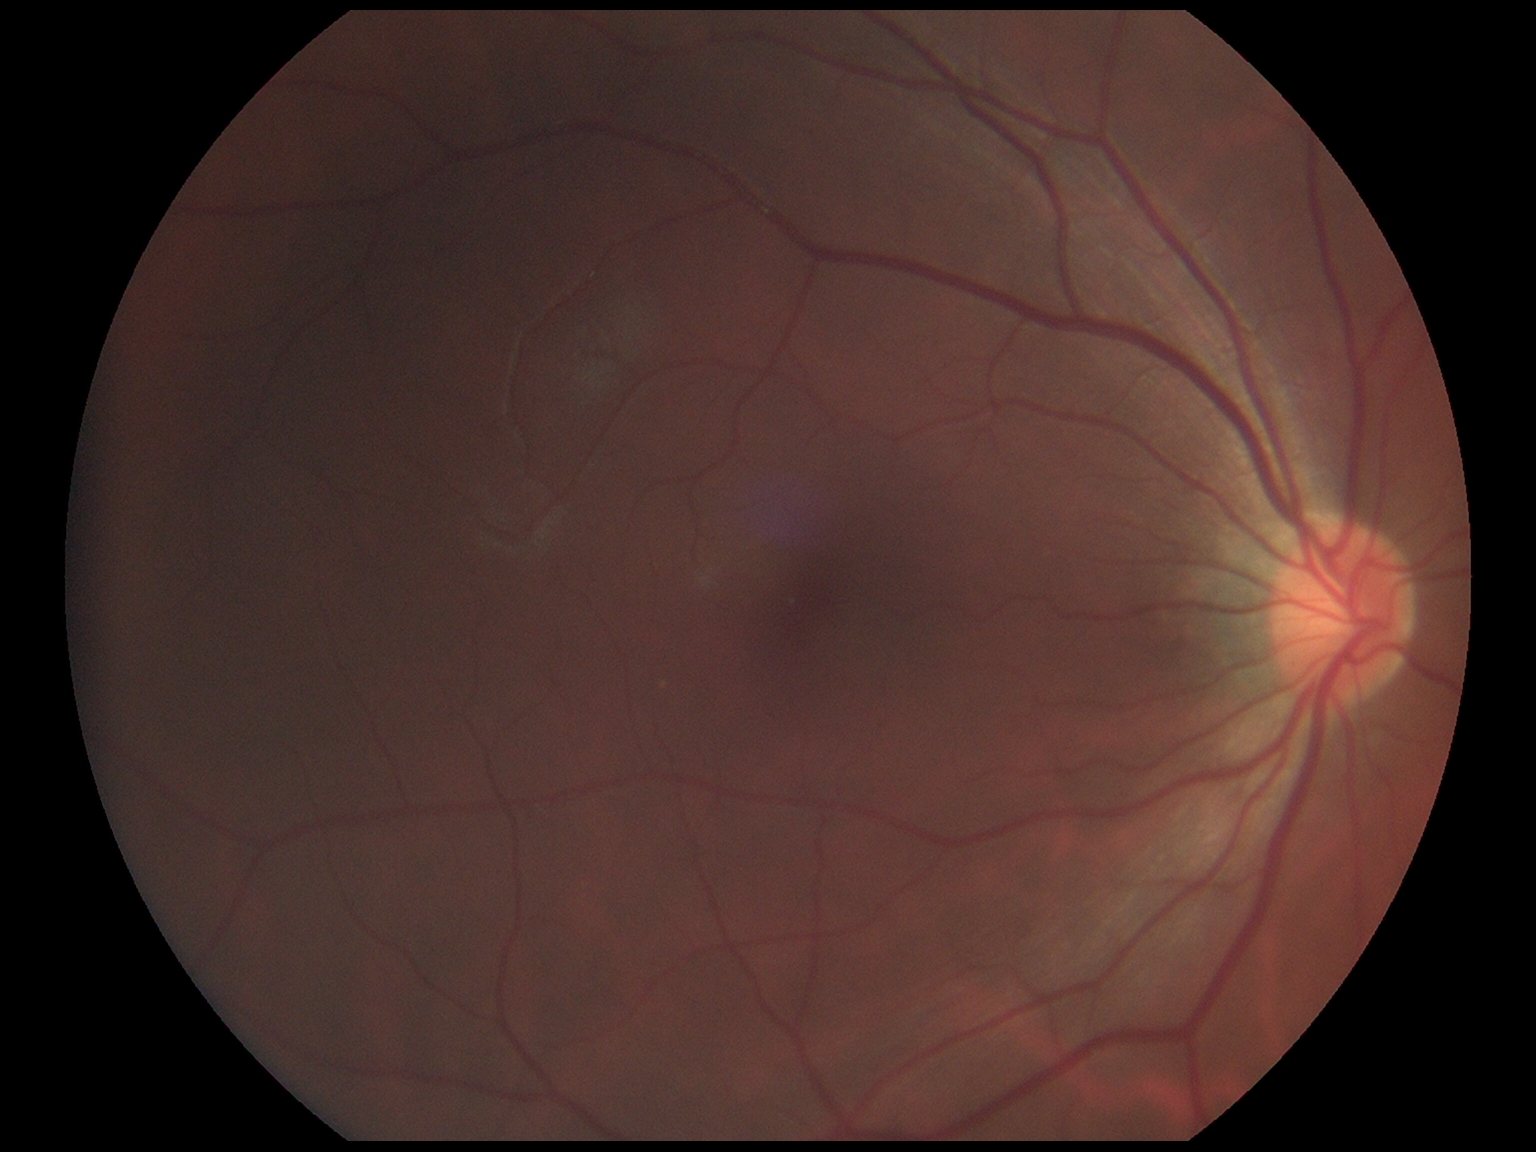
DR impression = no apparent DR
diabetic retinopathy severity = grade 0